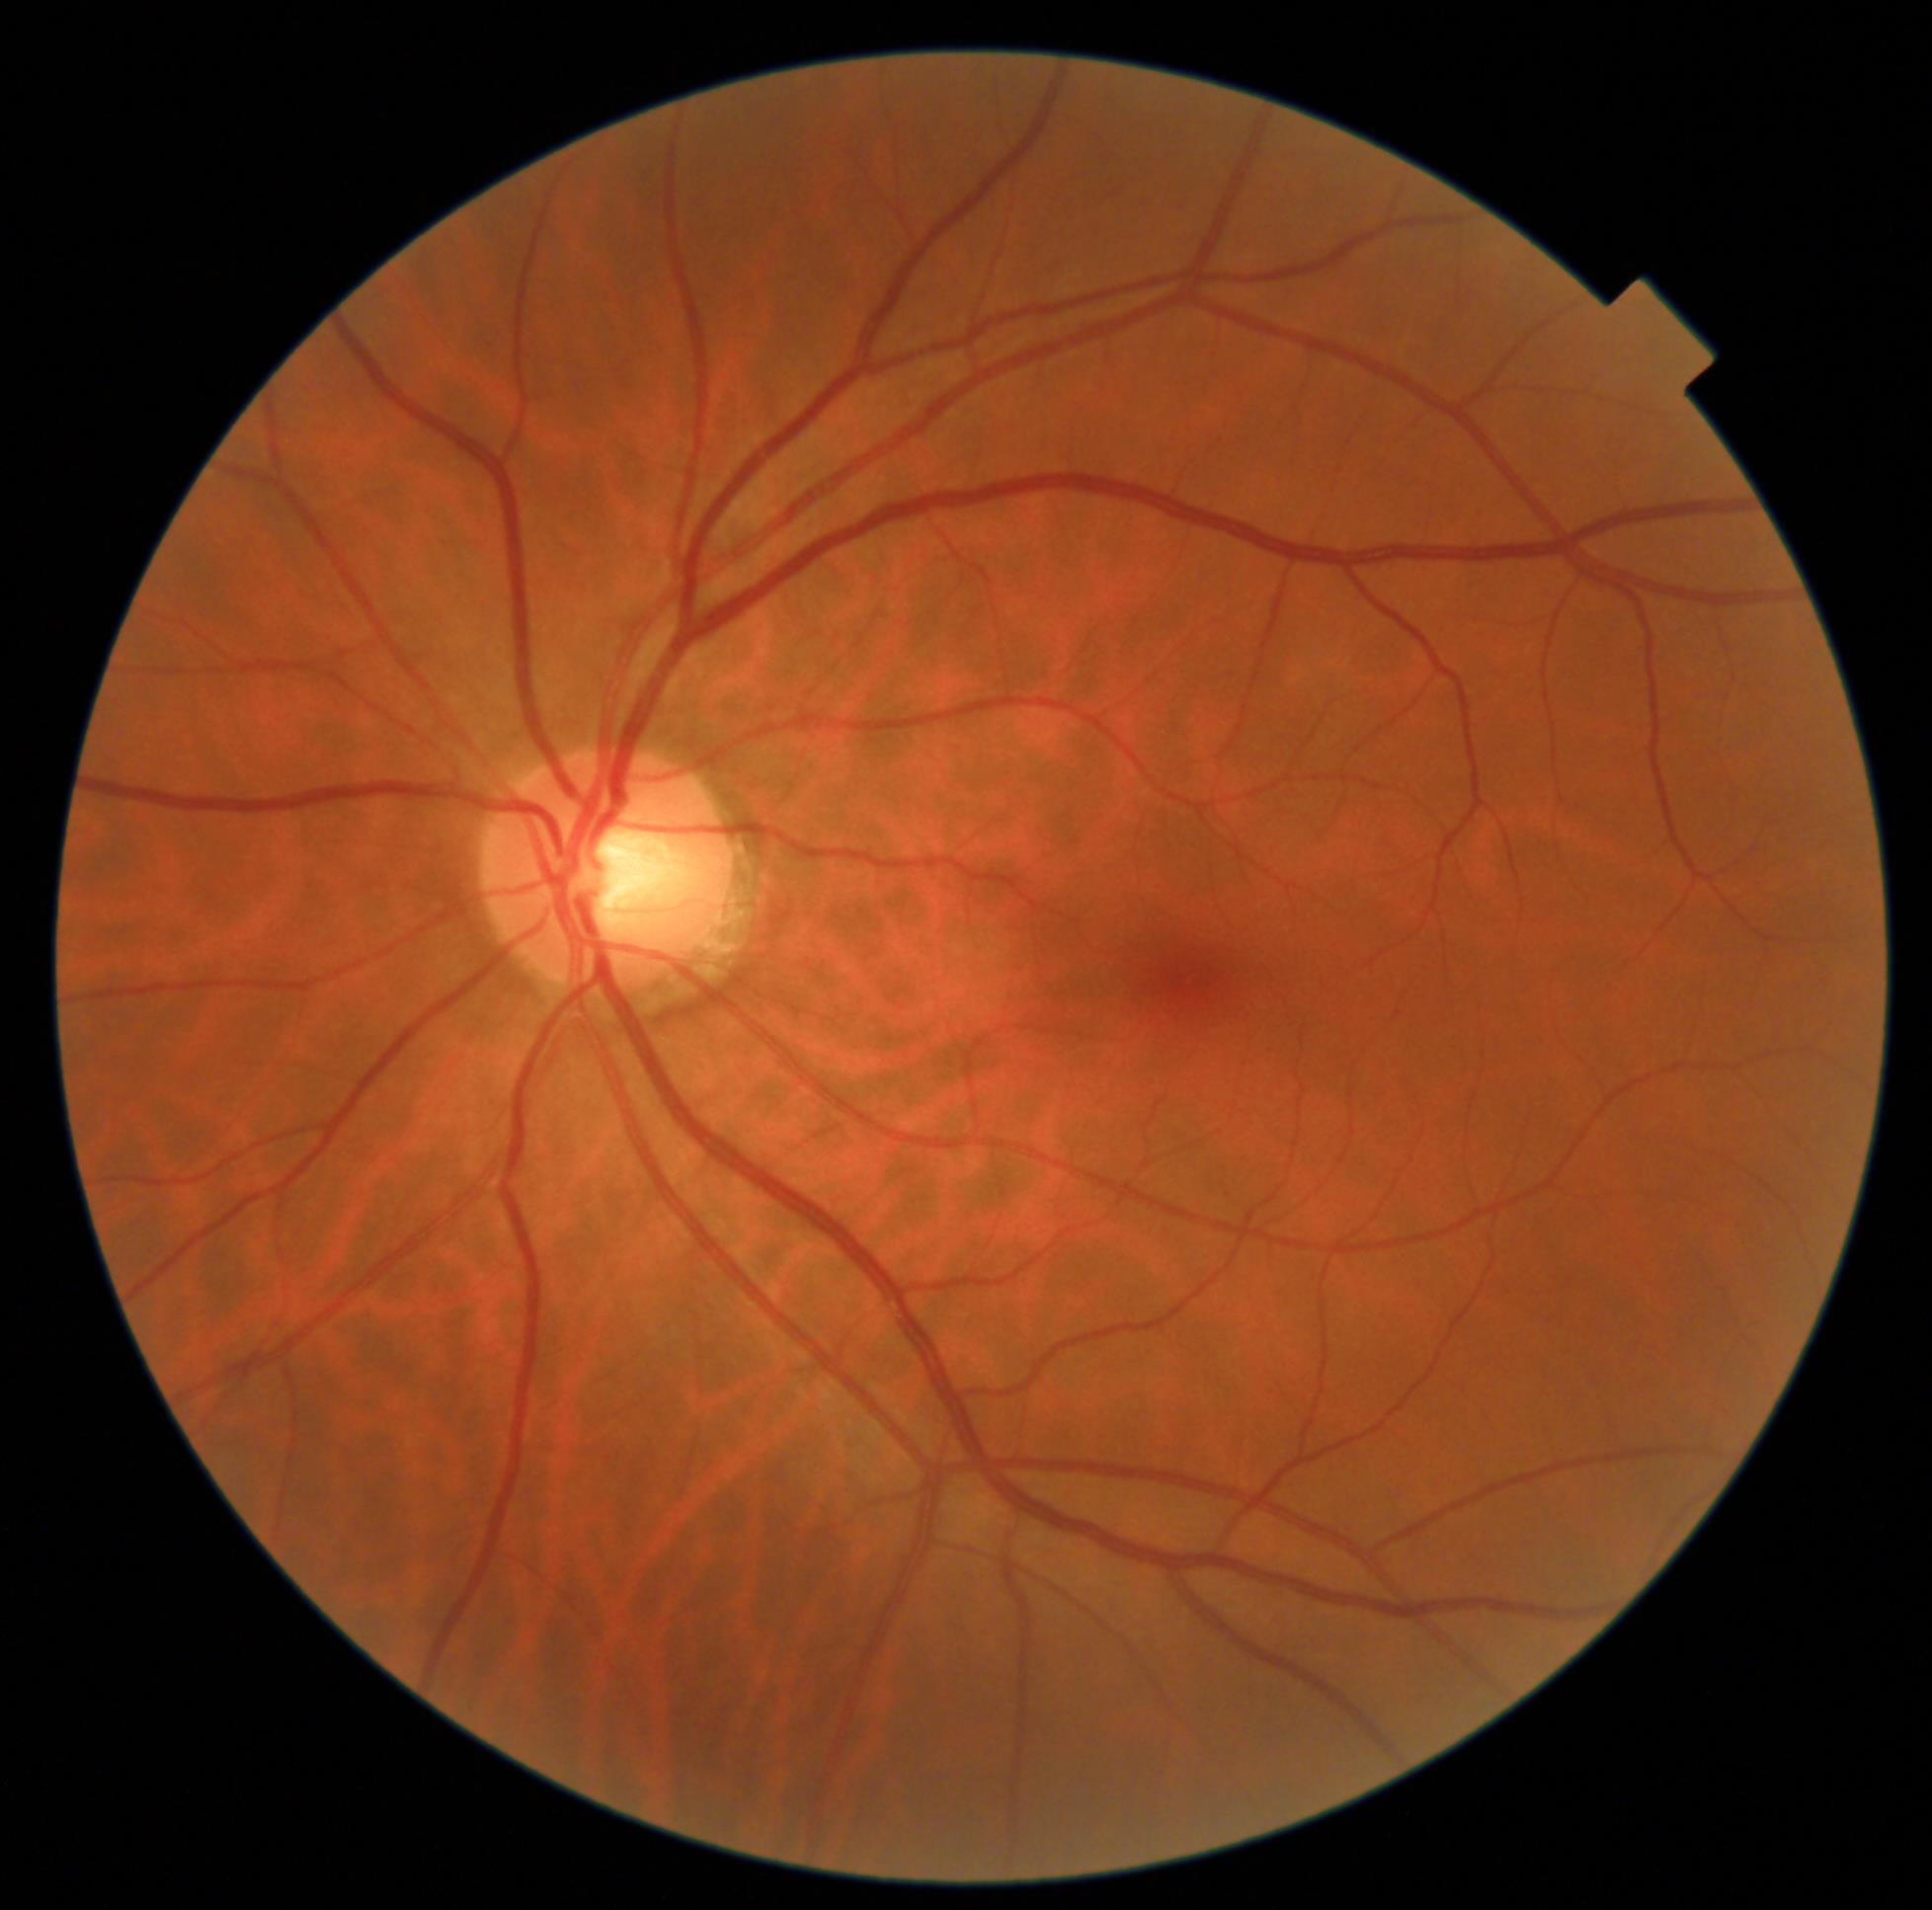
Diabetic retinopathy (DR) is grade 0 (no apparent retinopathy).